Without pupil dilation. Camera: NIDEK AFC-230
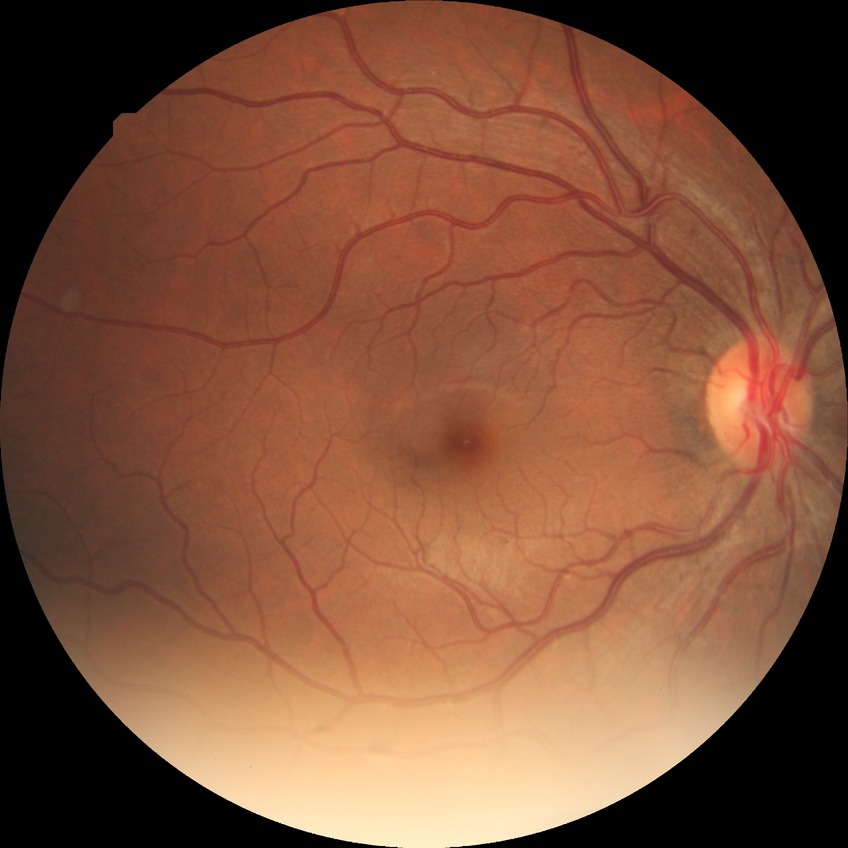 – diabetic retinopathy (DR): no diabetic retinopathy (NDR)